CFP — 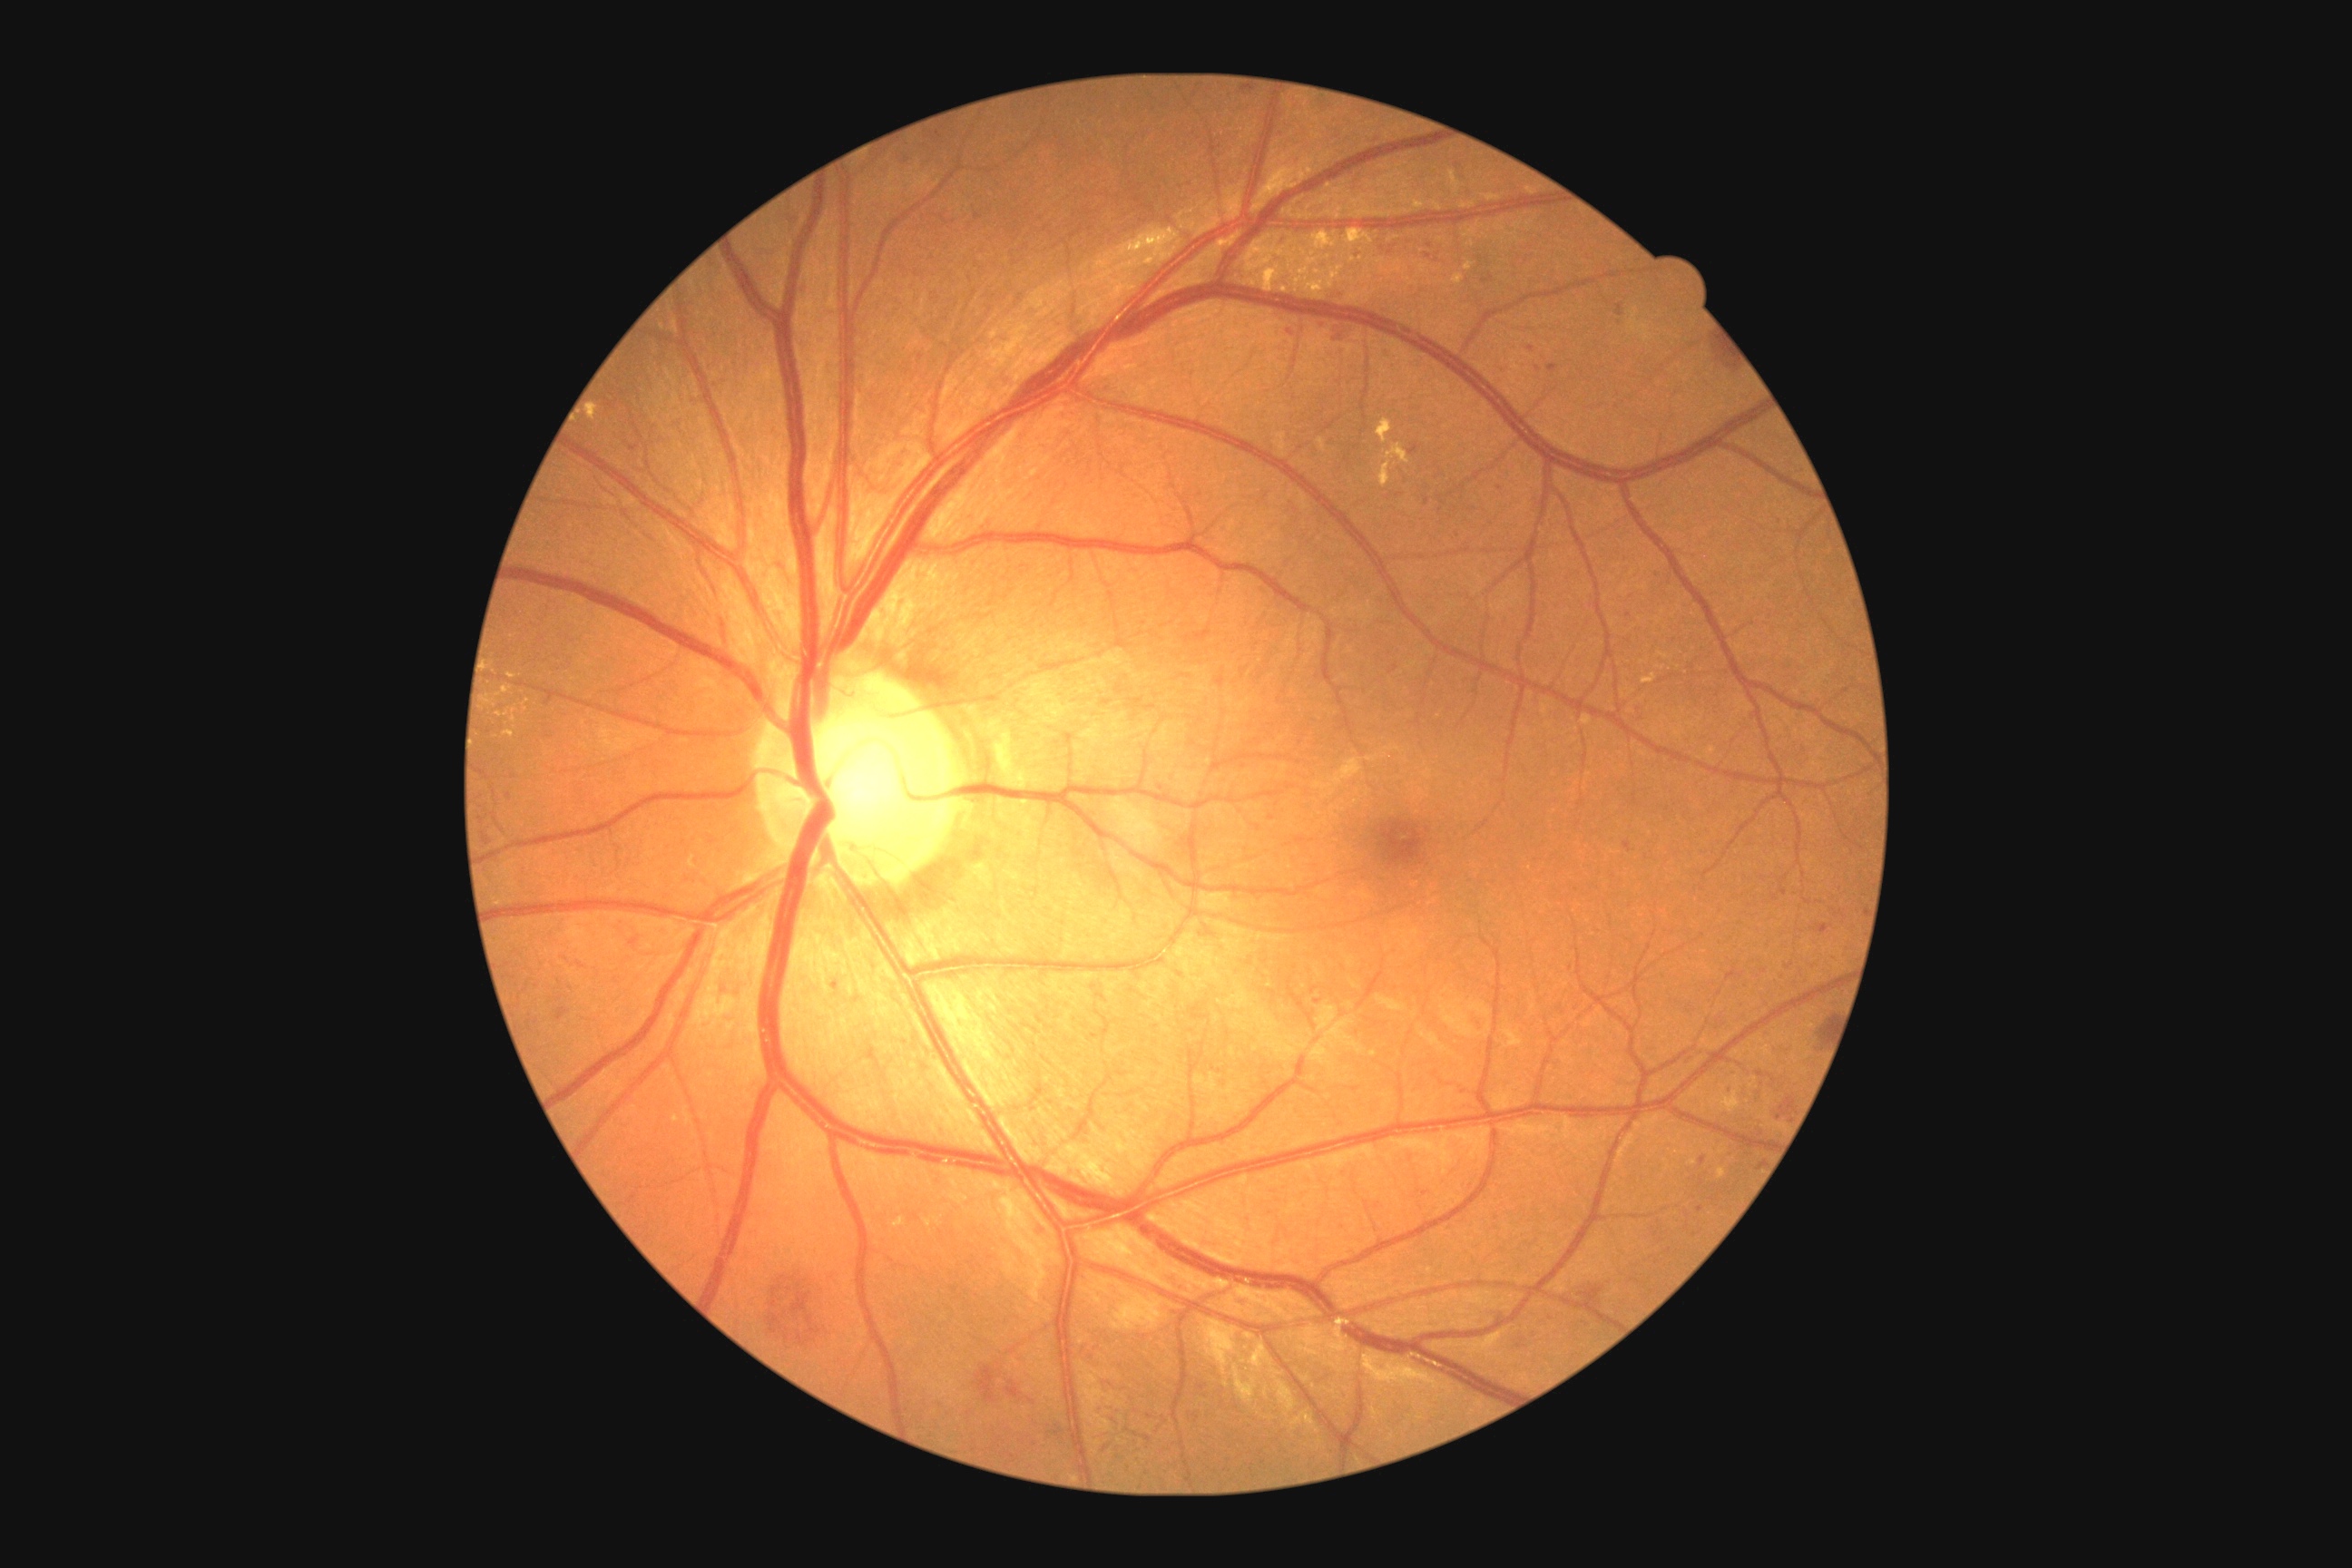
Diabetic retinopathy (DR): 3/4 — more than 20 intraretinal hemorrhages in each of 4 quadrants, definite venous beading in 2 or more quadrants, or prominent intraretinal microvascular abnormalities in 1 or more quadrants, with no signs of proliferative retinopathy.
Hemorrhages (HEs) include lesions at [left=1651, top=571, right=1661, bottom=580]; [left=1208, top=1063, right=1224, bottom=1075]; [left=852, top=152, right=888, bottom=179]; [left=999, top=375, right=1017, bottom=387]; [left=1279, top=340, right=1295, bottom=364]; [left=1482, top=271, right=1493, bottom=286]; [left=1228, top=179, right=1237, bottom=184]; [left=1805, top=1072, right=1812, bottom=1081]; [left=1032, top=1226, right=1048, bottom=1237]; [left=1725, top=1150, right=1734, bottom=1159]; [left=1772, top=1043, right=1794, bottom=1064]; [left=1277, top=130, right=1288, bottom=139]; [left=1210, top=146, right=1219, bottom=153]; [left=1409, top=447, right=1418, bottom=455]; [left=1284, top=326, right=1295, bottom=337].
HEs (small, approximate centers) near pt(1221, 682); pt(633, 943).